Image size 2228x1652: 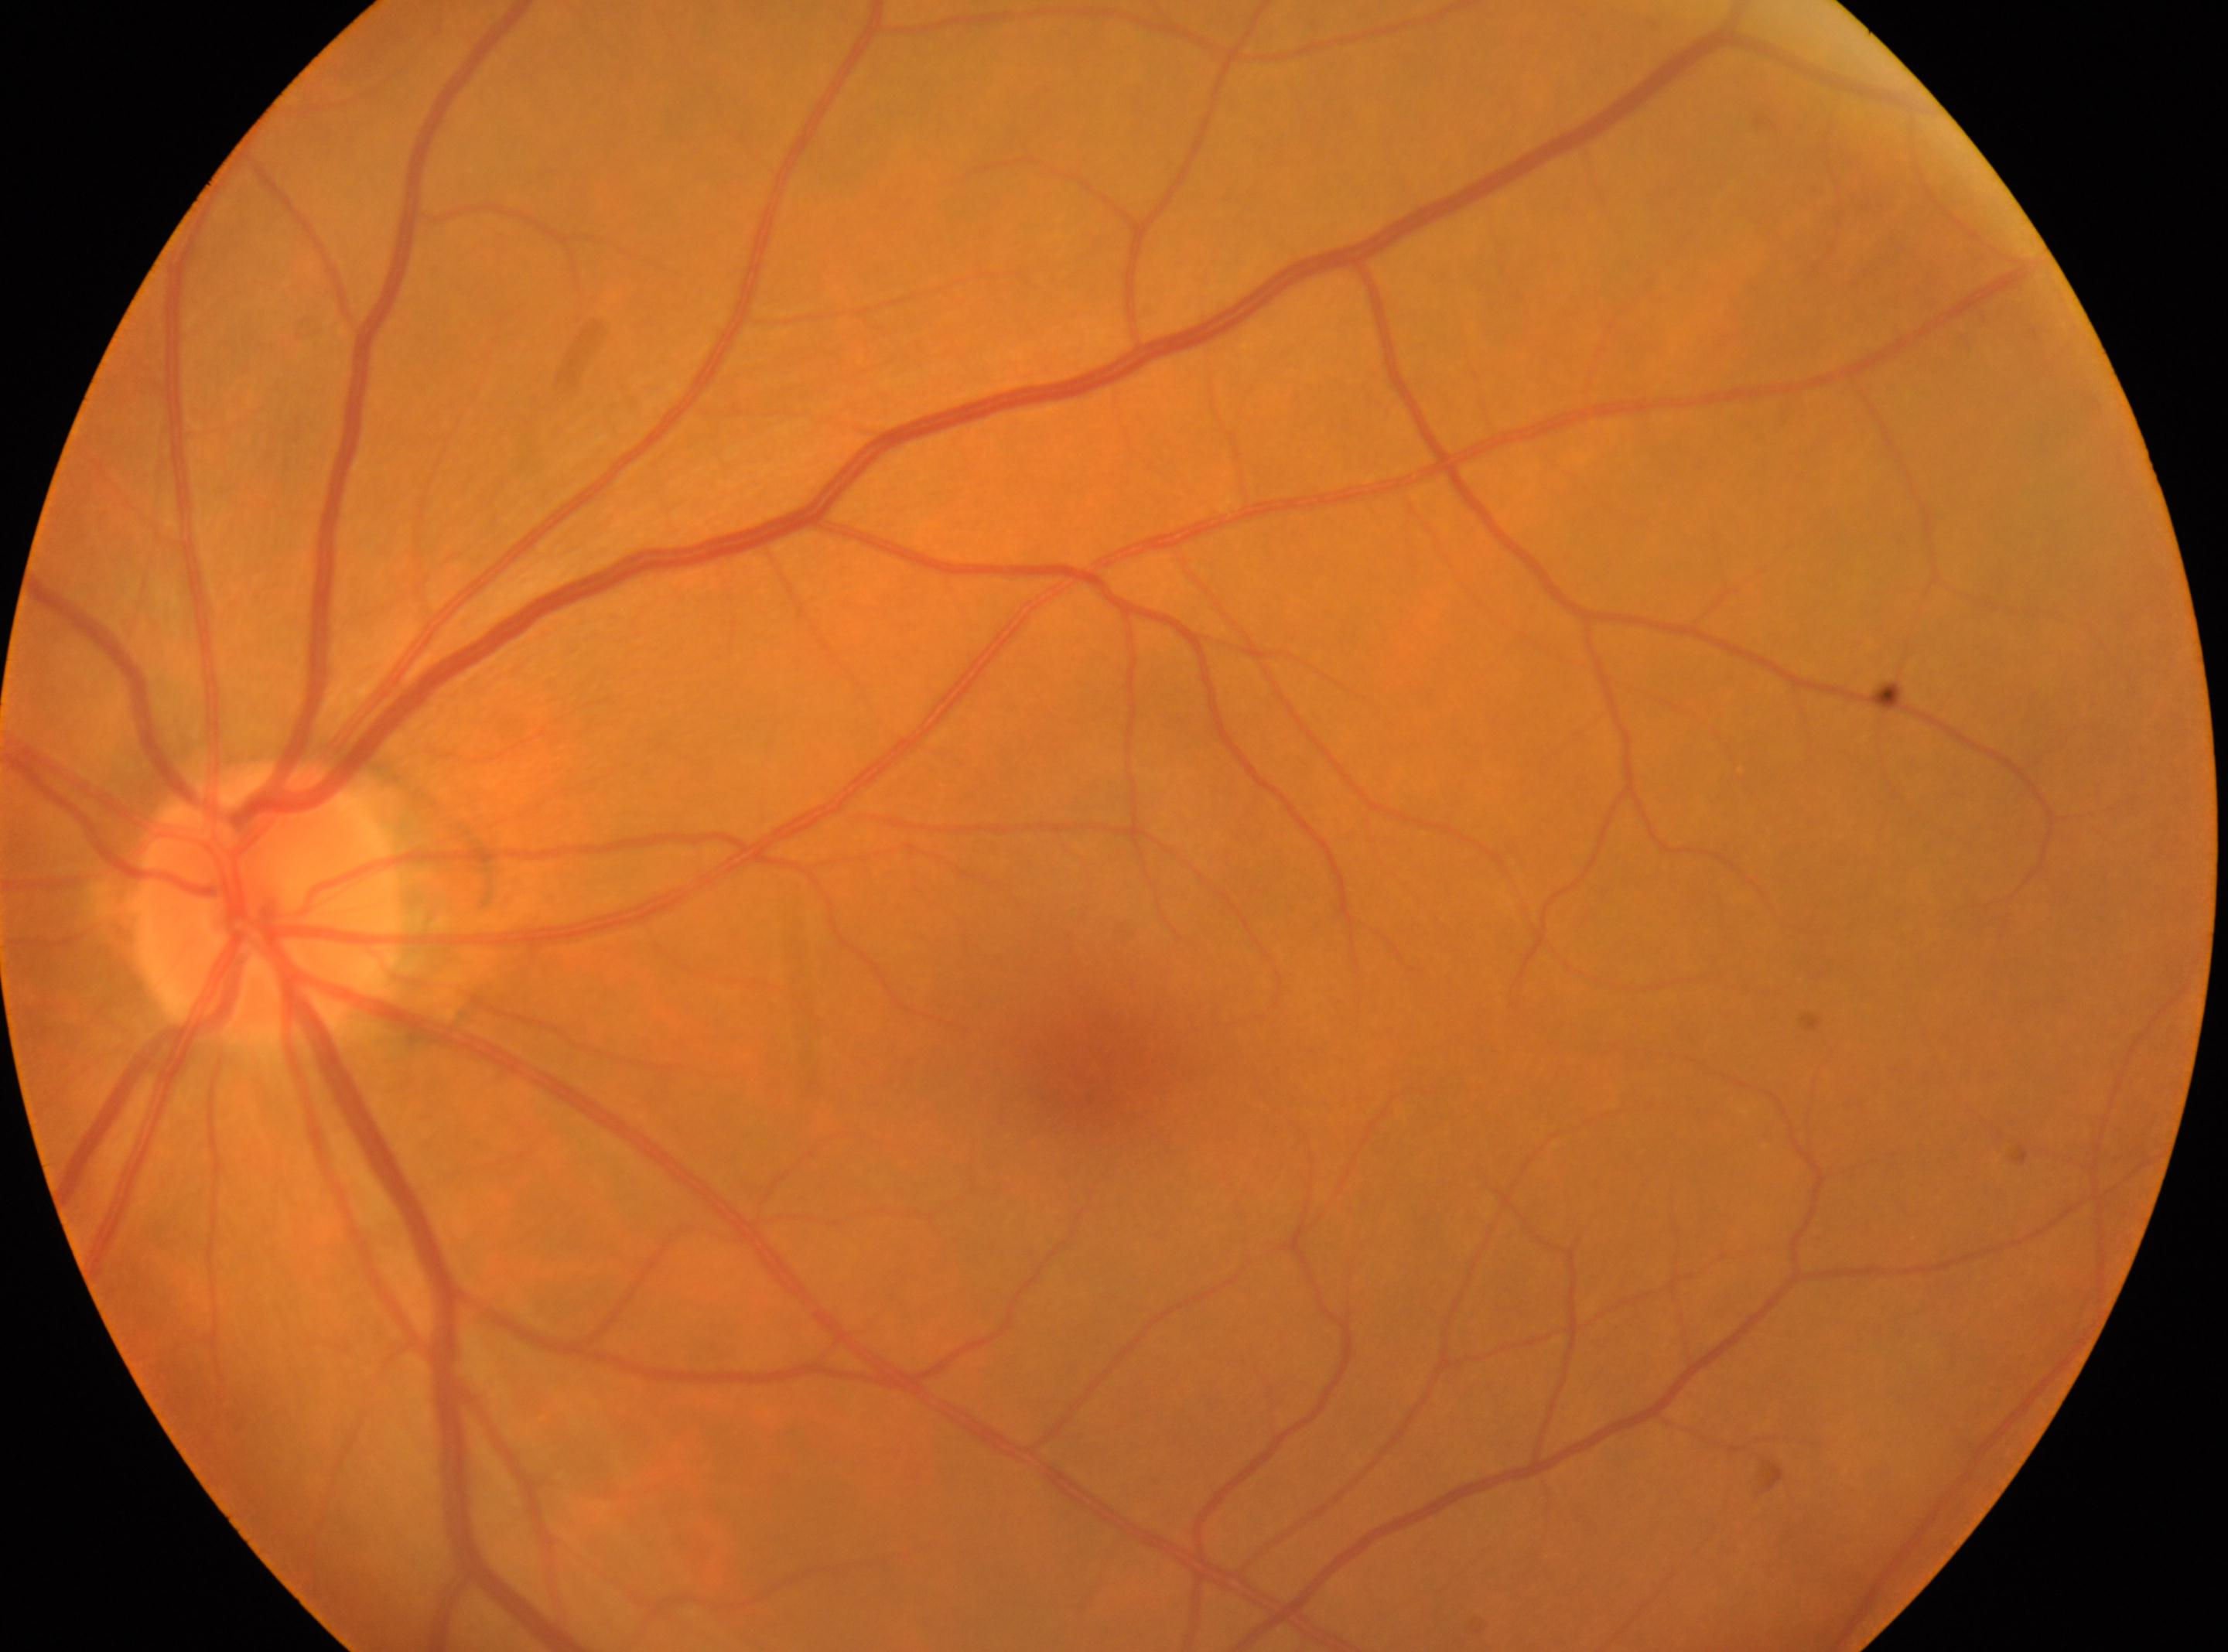
Findings:
– optic disc center — x=265, y=905
– fovea centralis — x=1099, y=1077
– DR impression — No diabetic retinal disease findings
– diabetic retinopathy severity — 0/4 — no visible signs of diabetic retinopathy
– laterality — the left eye